Intraocular pressure (IOP) 23 mmHg by pneumatic tonometry · autorefraction: +2 -1.5 x 133 · non-mydriatic · Topcon TRC-NW400 · 54 years old · 30° field of view · central corneal thickness: 599 µm · sex: female — 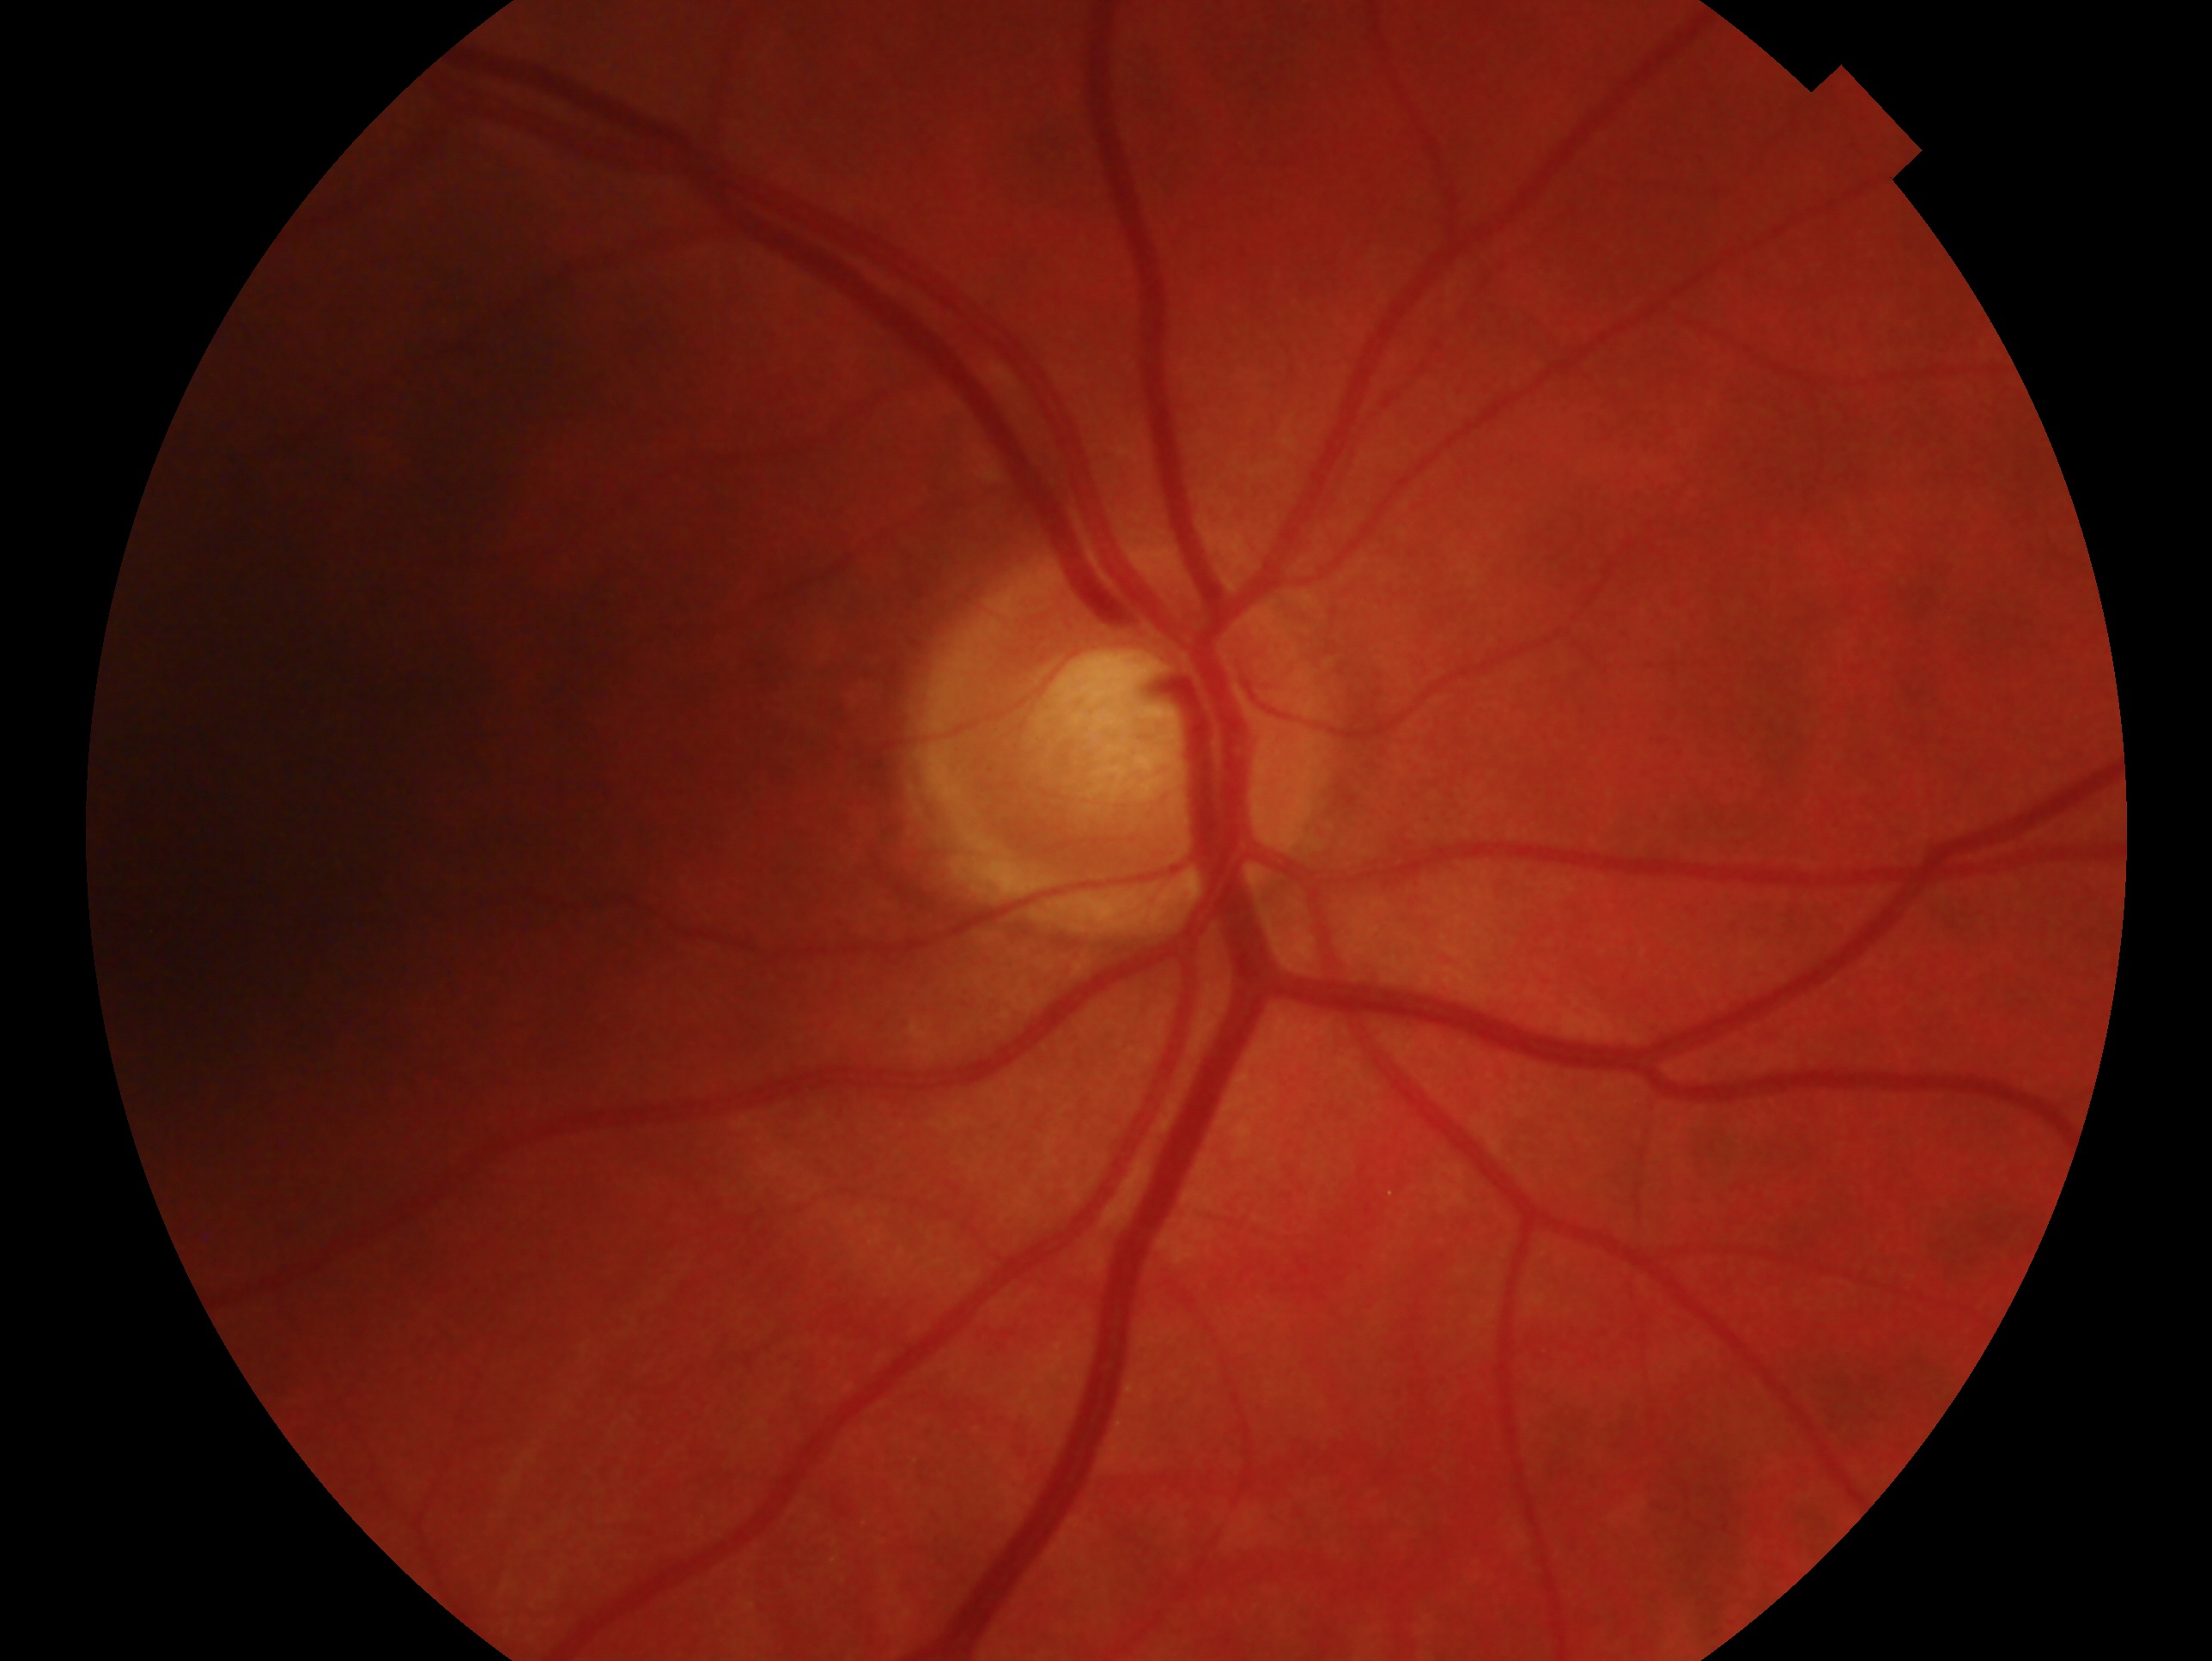

glaucoma status=negative for glaucoma; laterality=right eye.